45-degree field of view · color fundus photograph · 1932x1932
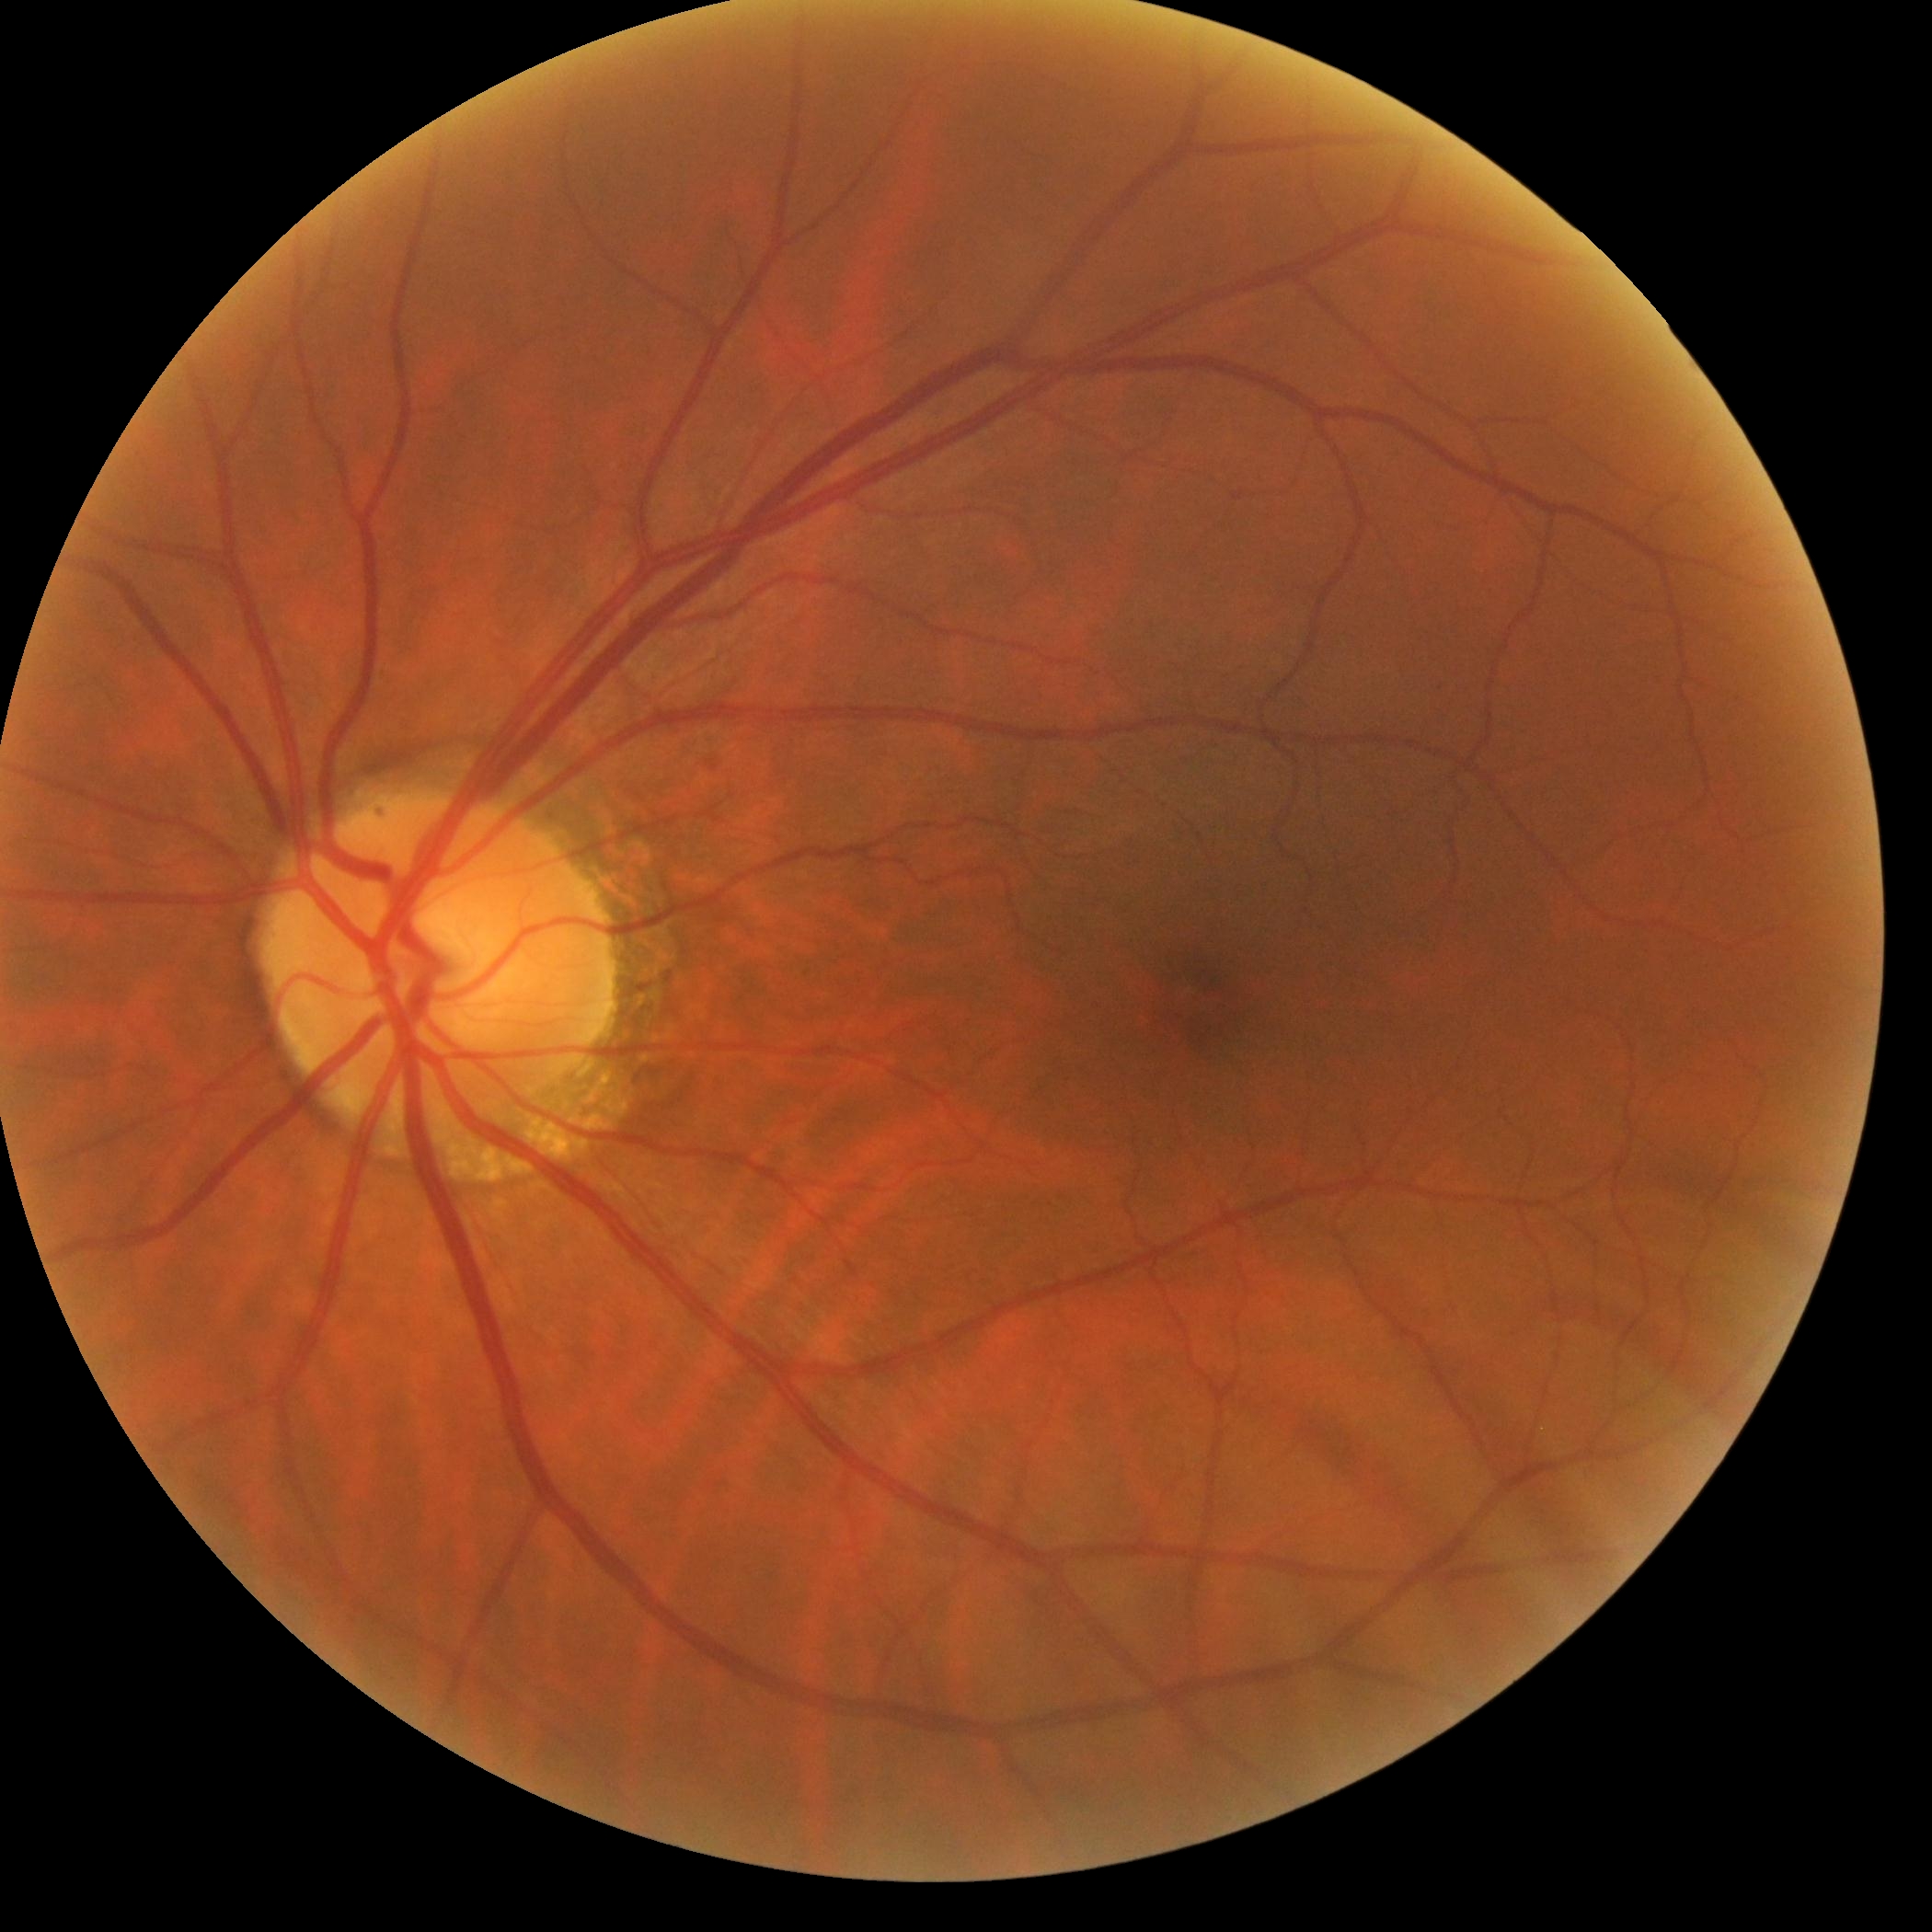
DR severity: grade 0 (no apparent retinopathy).